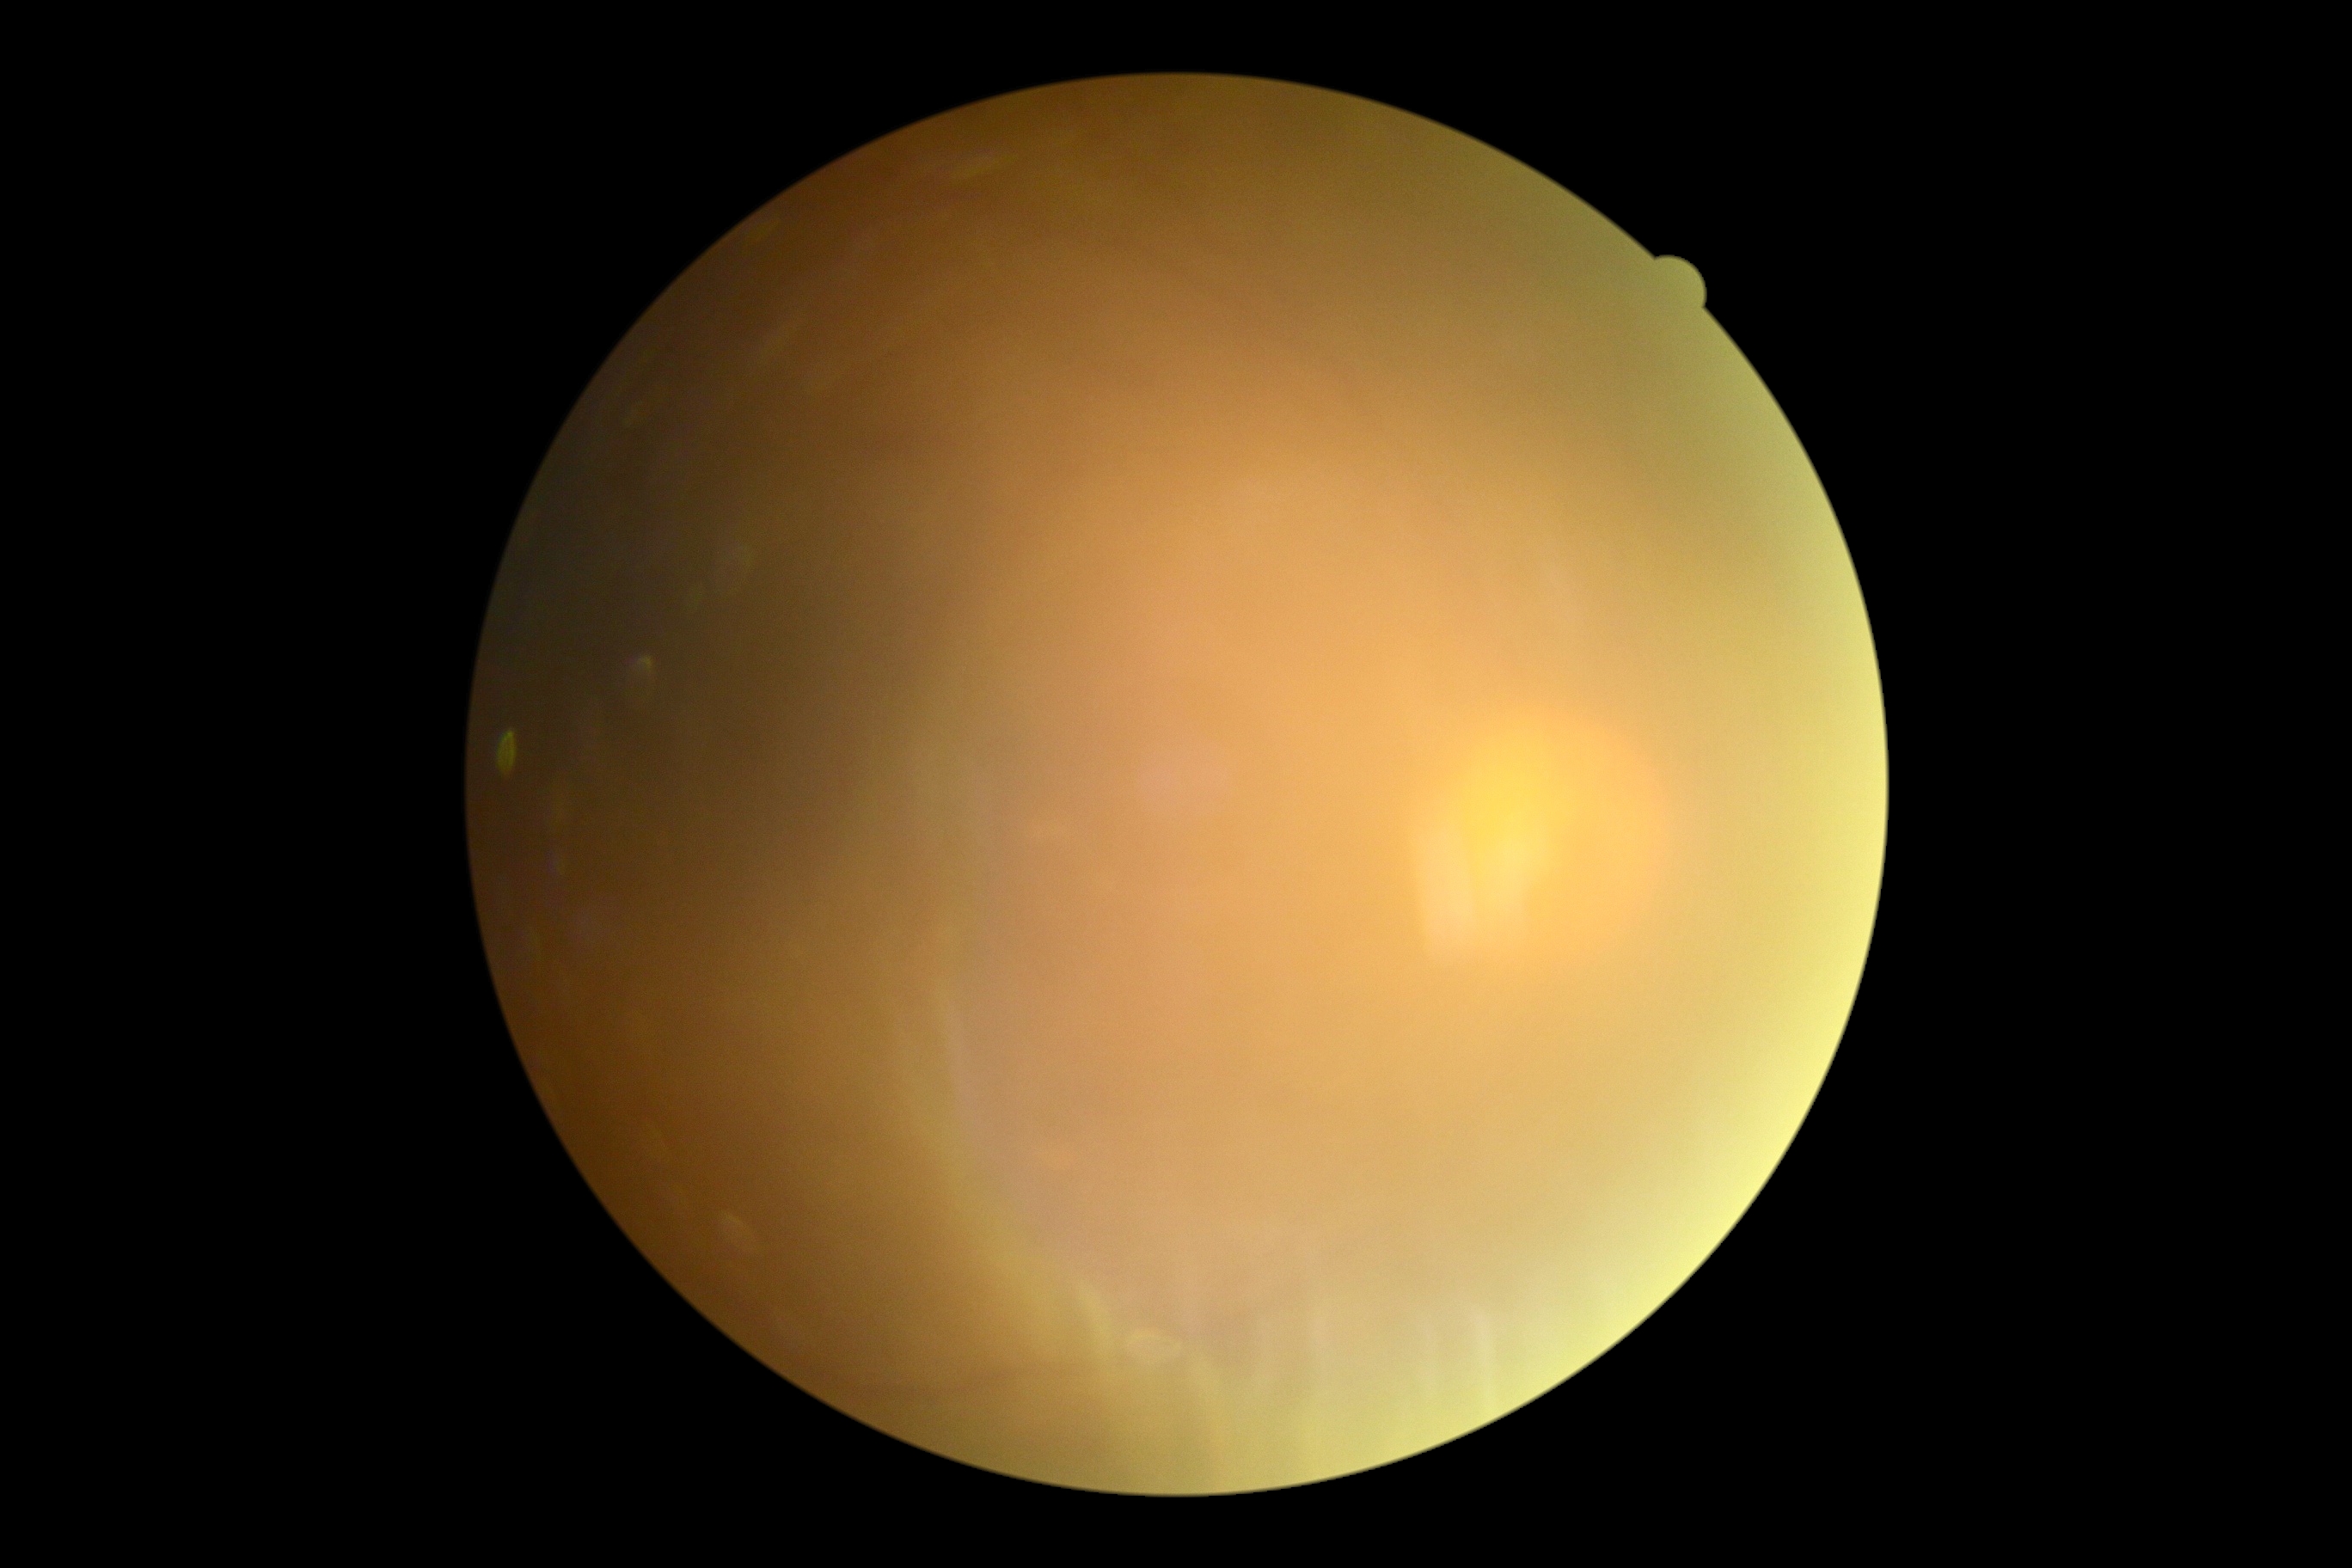 Diabetic retinopathy: ungradable due to poor image quality.